Nonmydriatic fundus photograph; 45-degree field of view; NIDEK AFC-230; 848x848px.
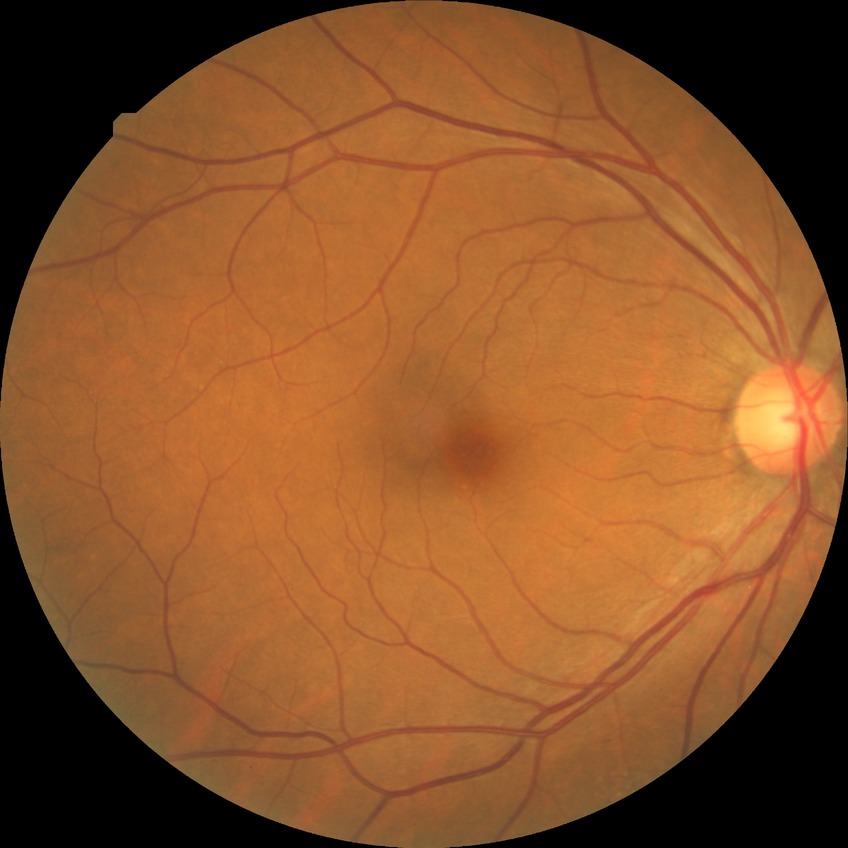 Diabetic retinopathy (DR) is no diabetic retinopathy (NDR).